45 degree fundus photograph, color fundus photograph
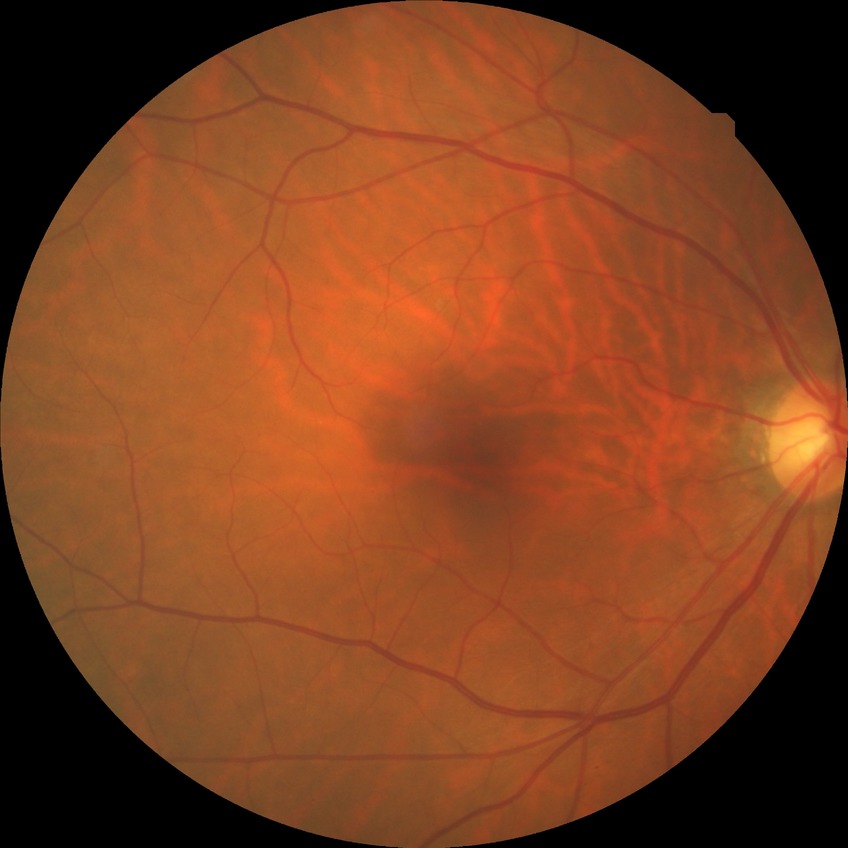
Davis grading: no diabetic retinopathy